FOV: 45 degrees:
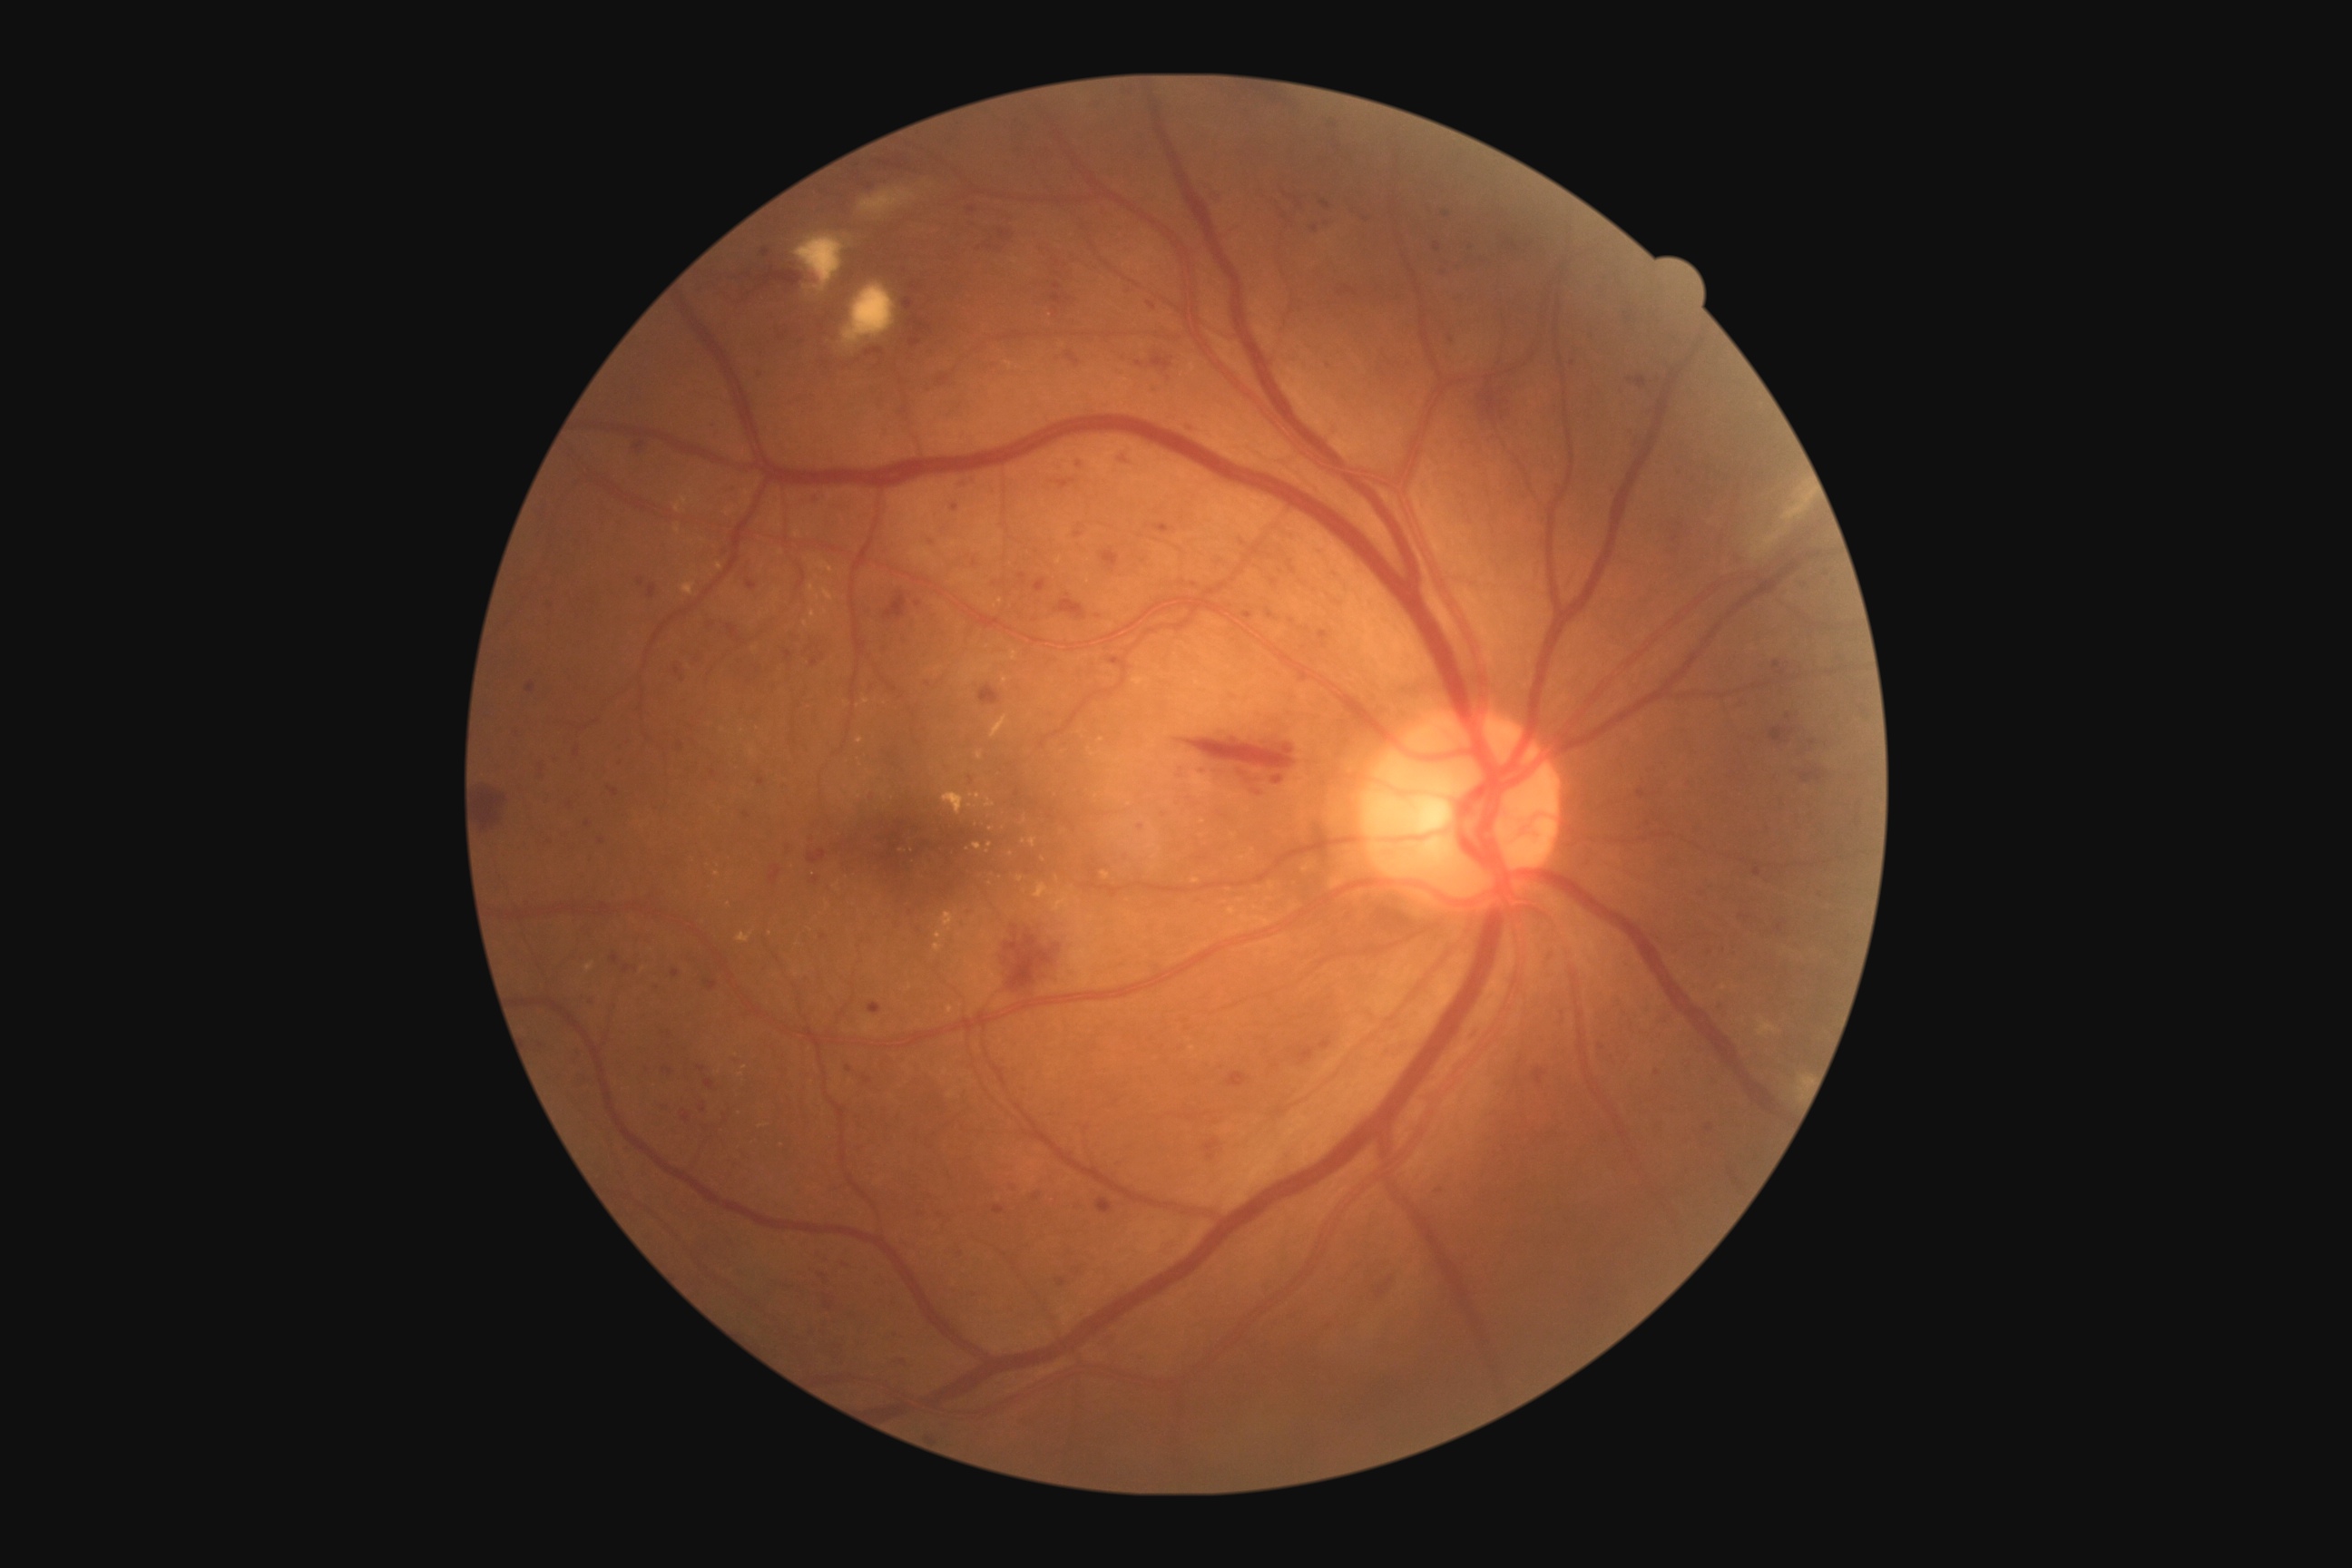

DR severity: grade 3 (severe NPDR).